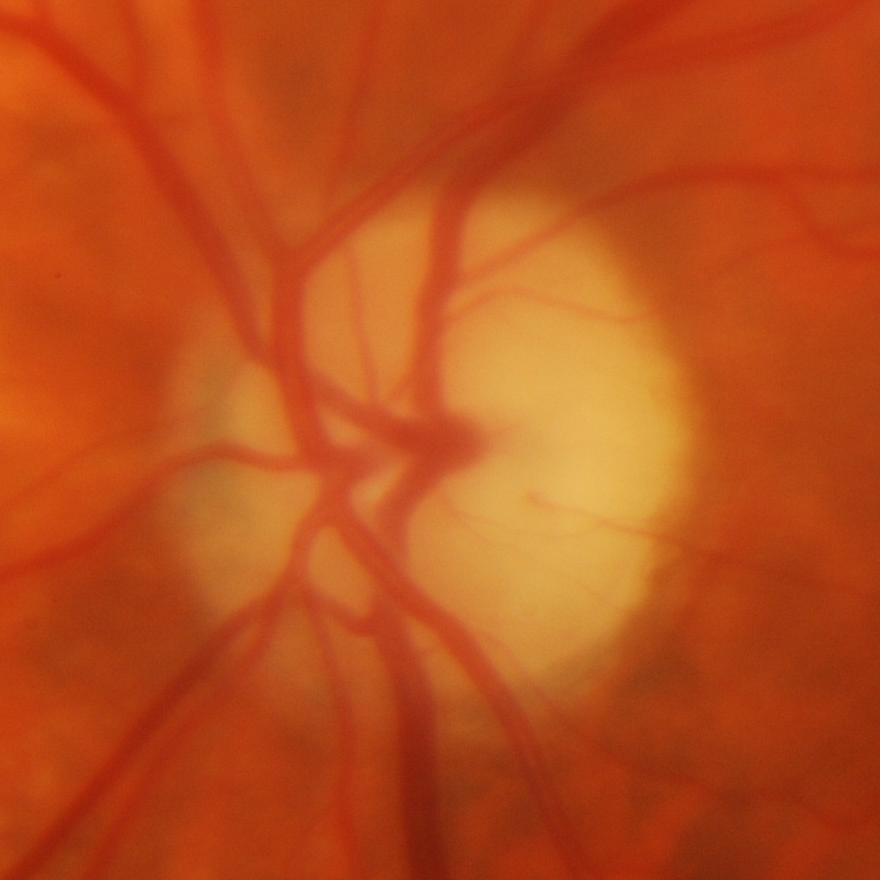

Optic disc photograph showing glaucomatous findings.